Portable fundus photograph; FOV: 60 degrees — 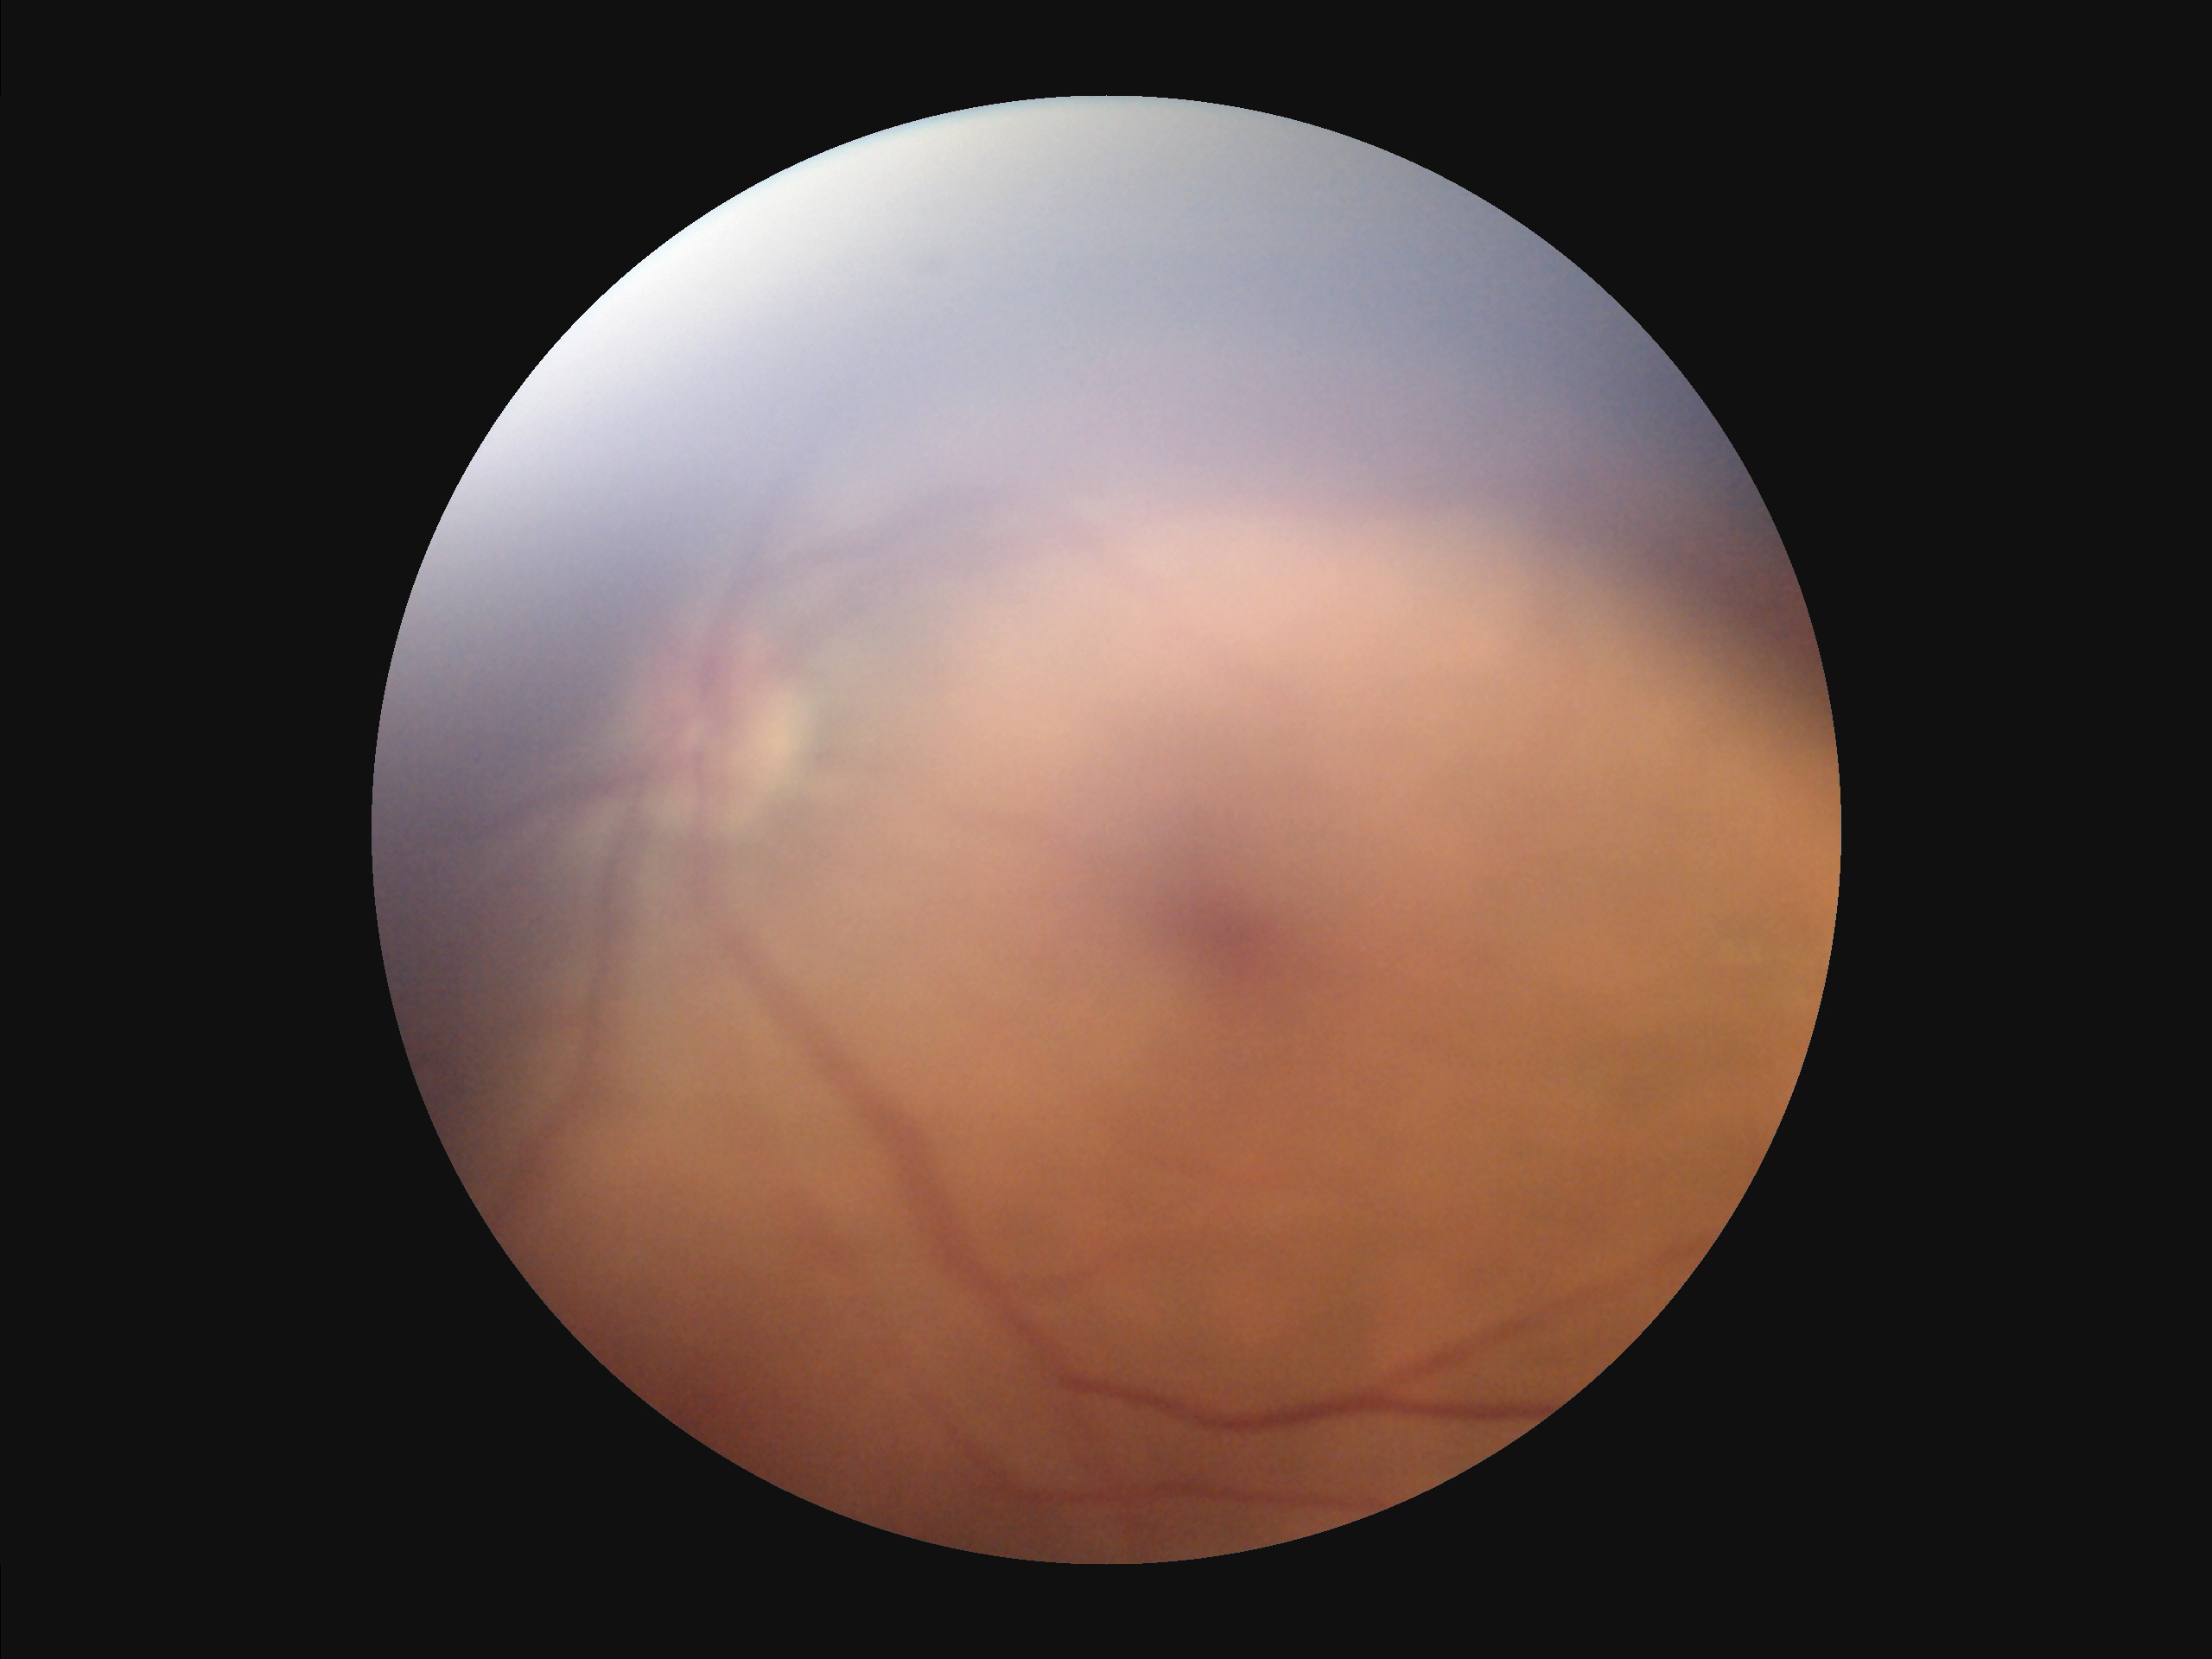

Image quality assessment: contrast: reduced; overall: inadequate; focus: reduced; illumination/color: poor.